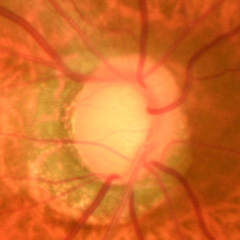
Early glaucomatous optic neuropathy.